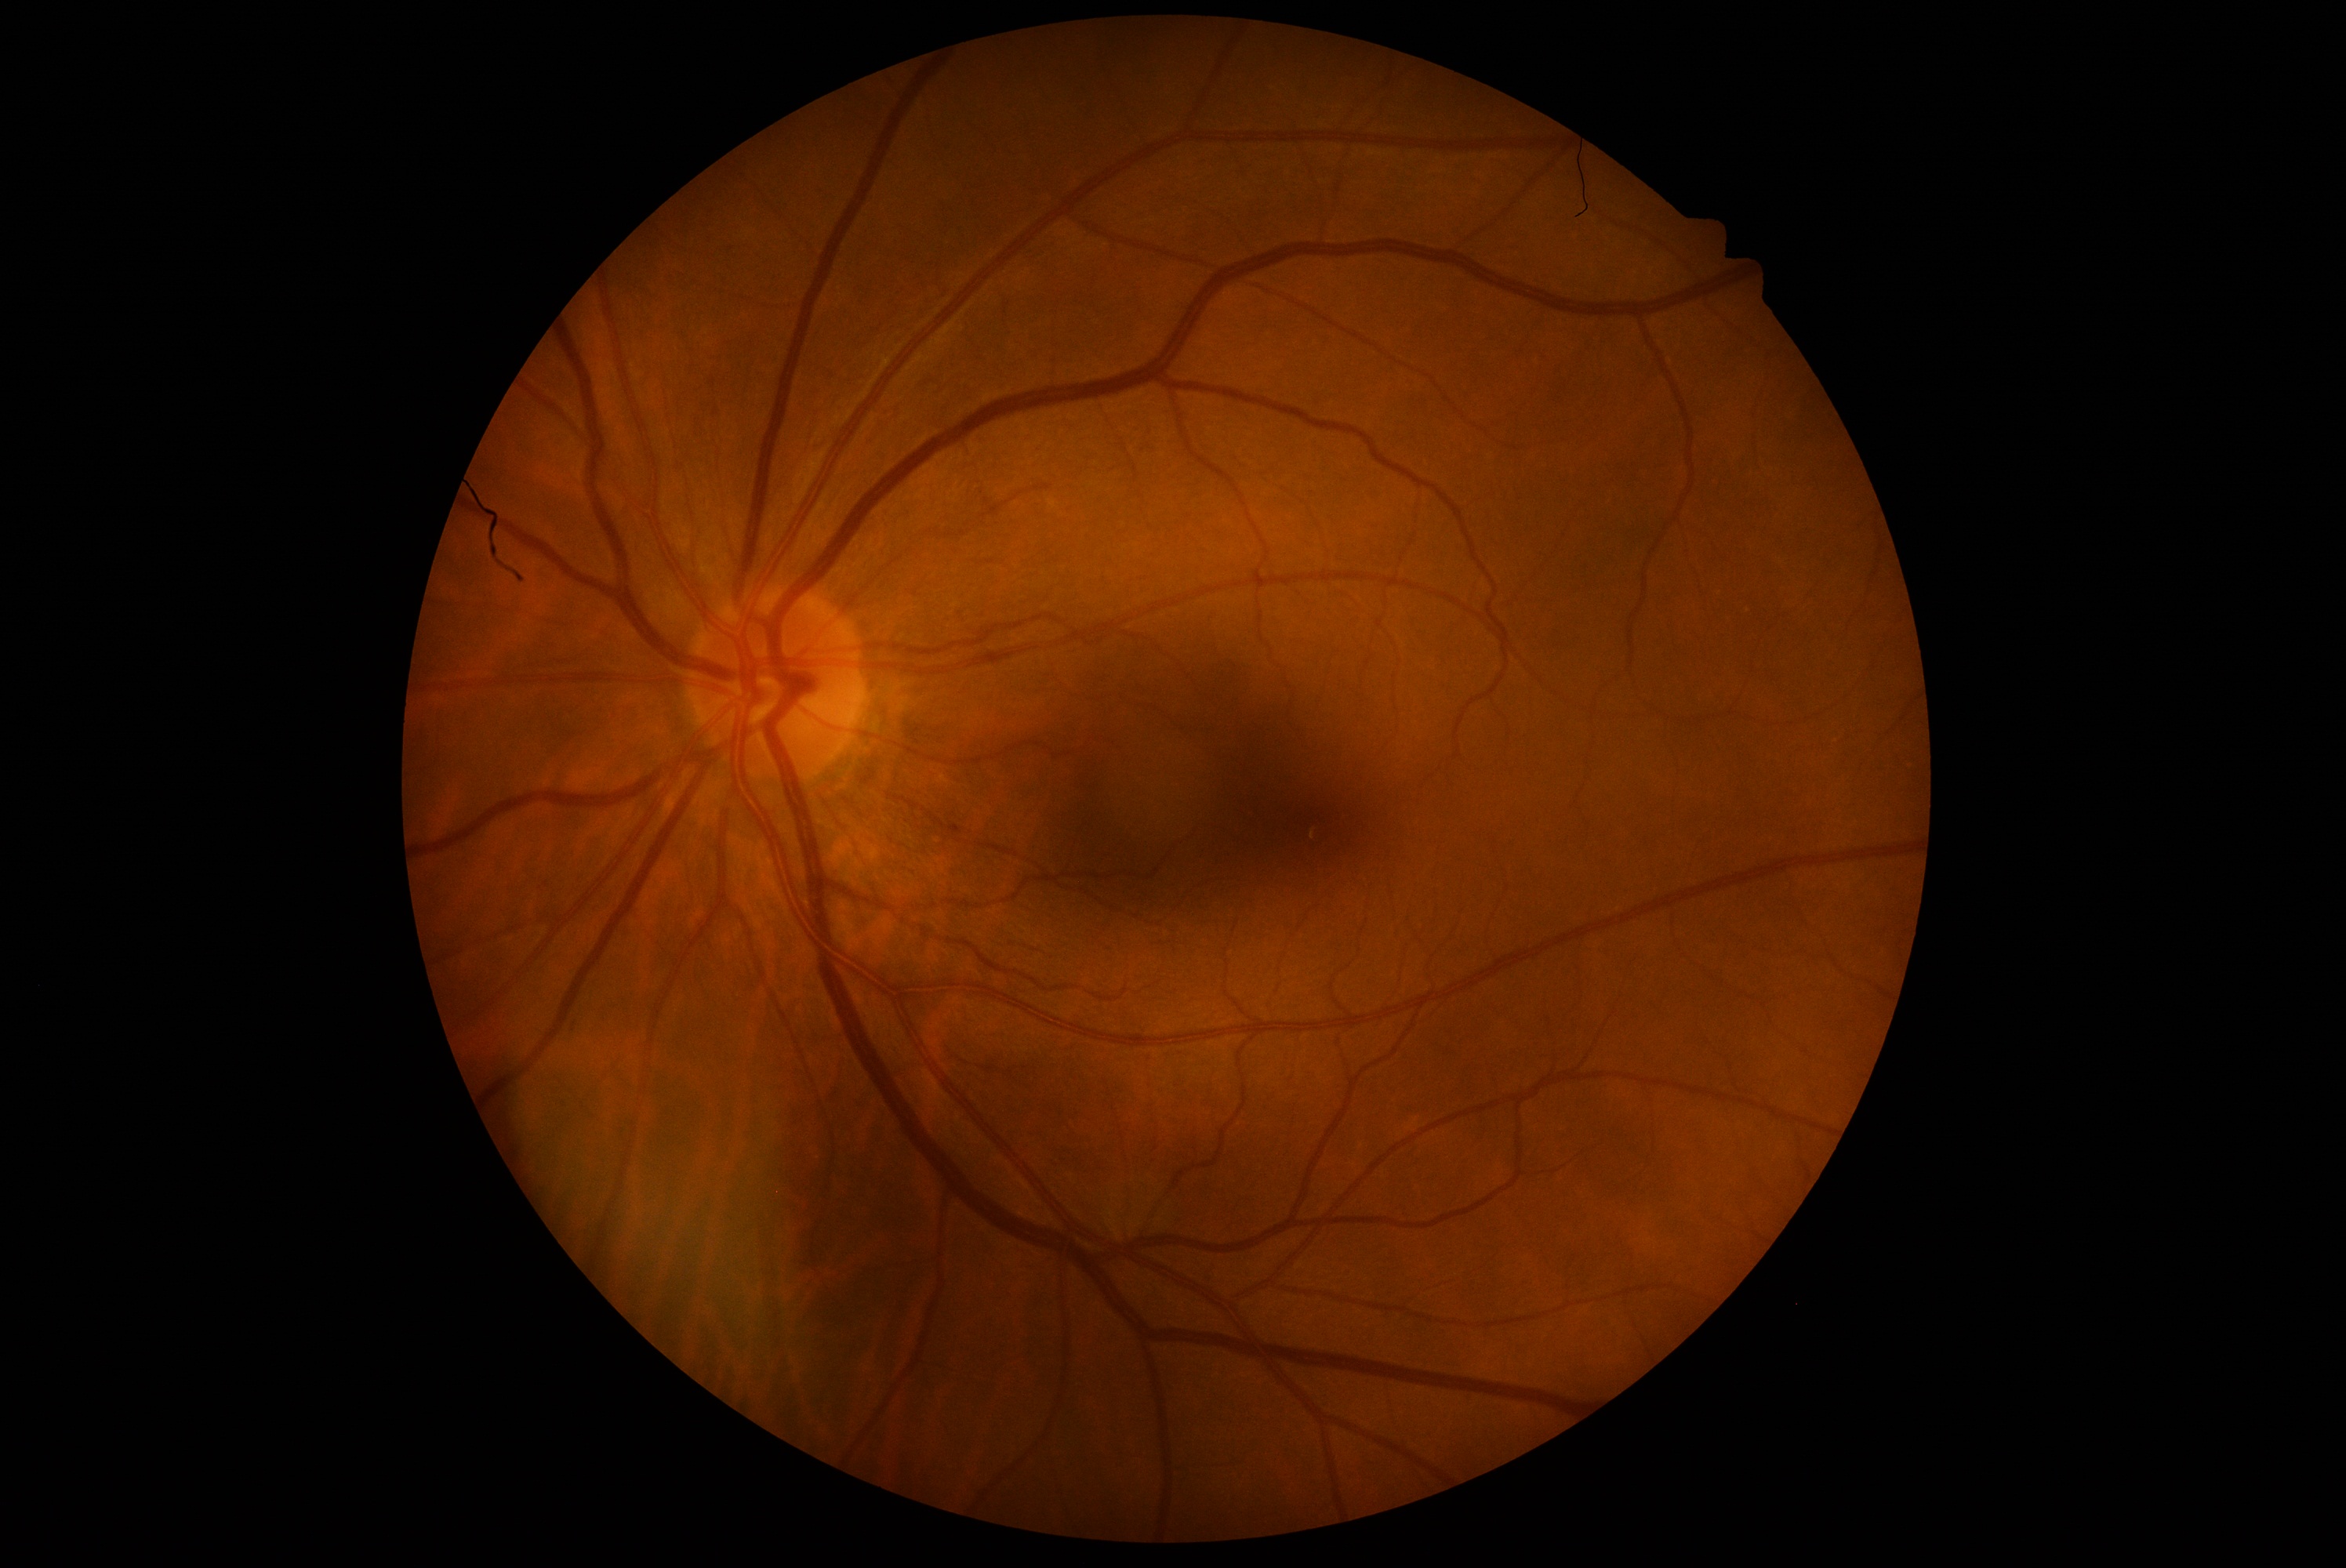

DR severity is 0/4 — no visible signs of diabetic retinopathy.